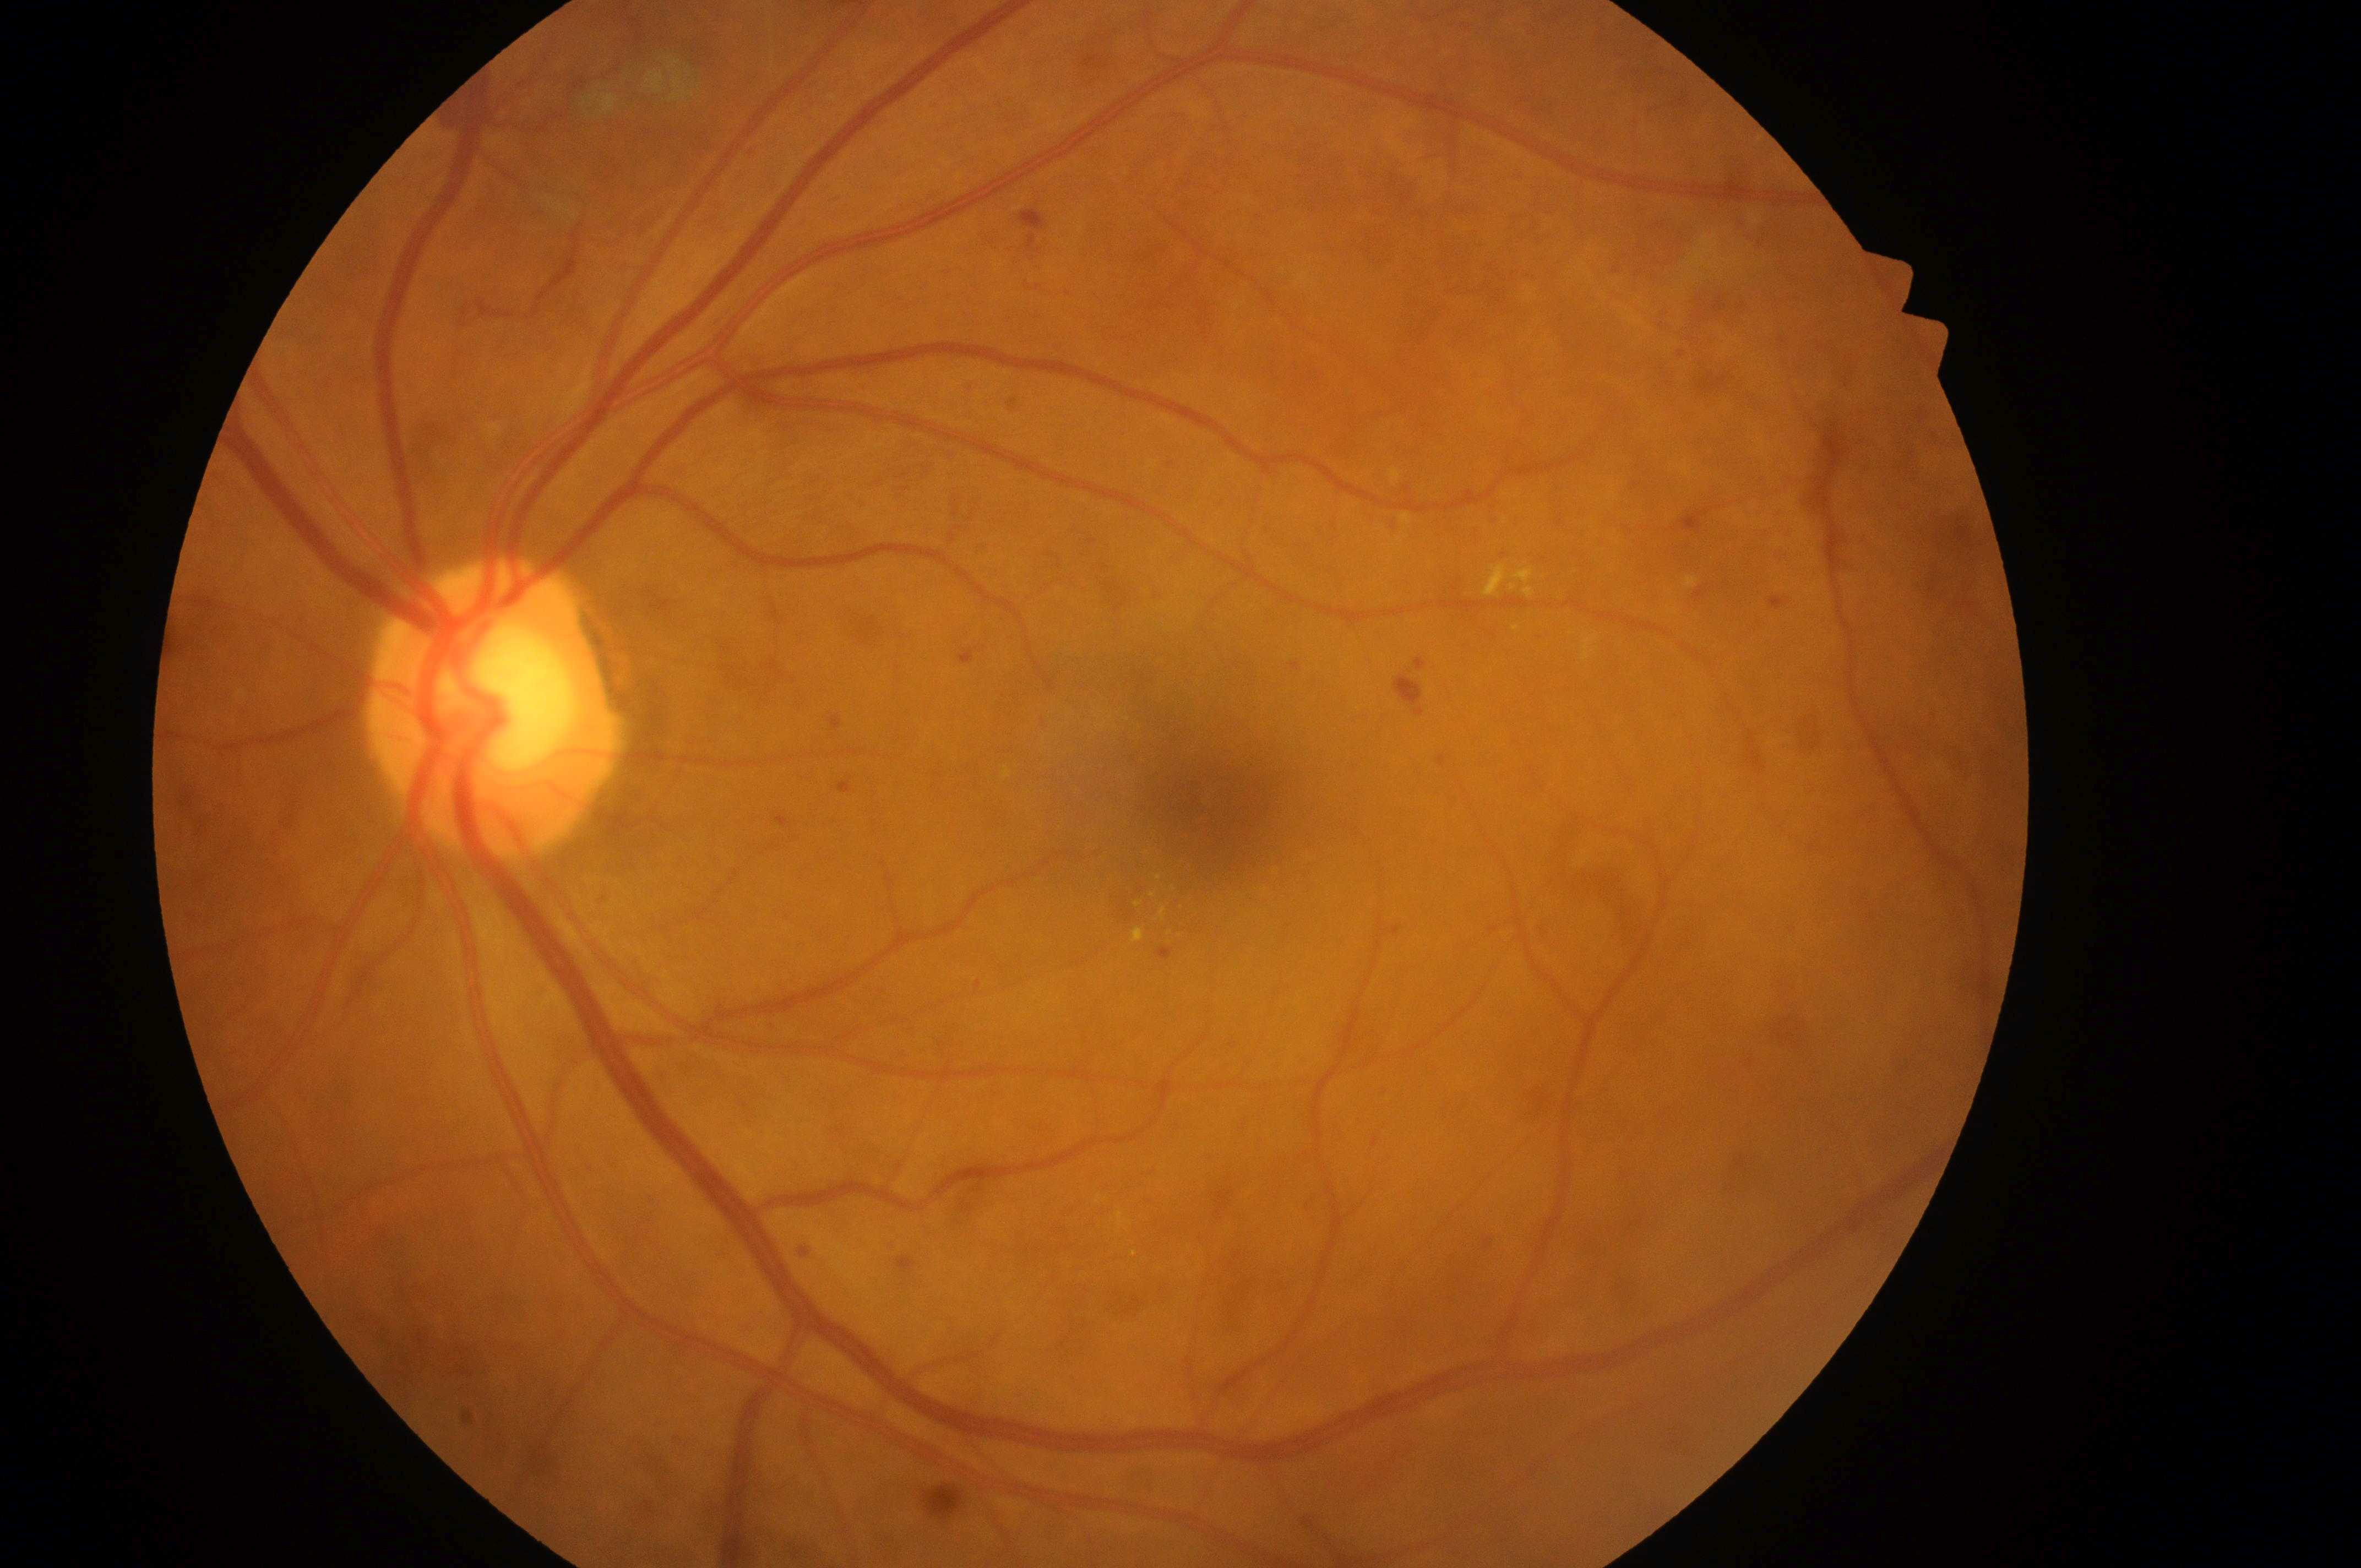

diabetic retinopathy: moderate non-proliferative diabetic retinopathy (grade 2); macular center: (1213,816); disc center: (493,715); risk of macular edema: grade 2 (high risk); laterality: left eye.